Retinal fundus photograph; 1659x2212px.
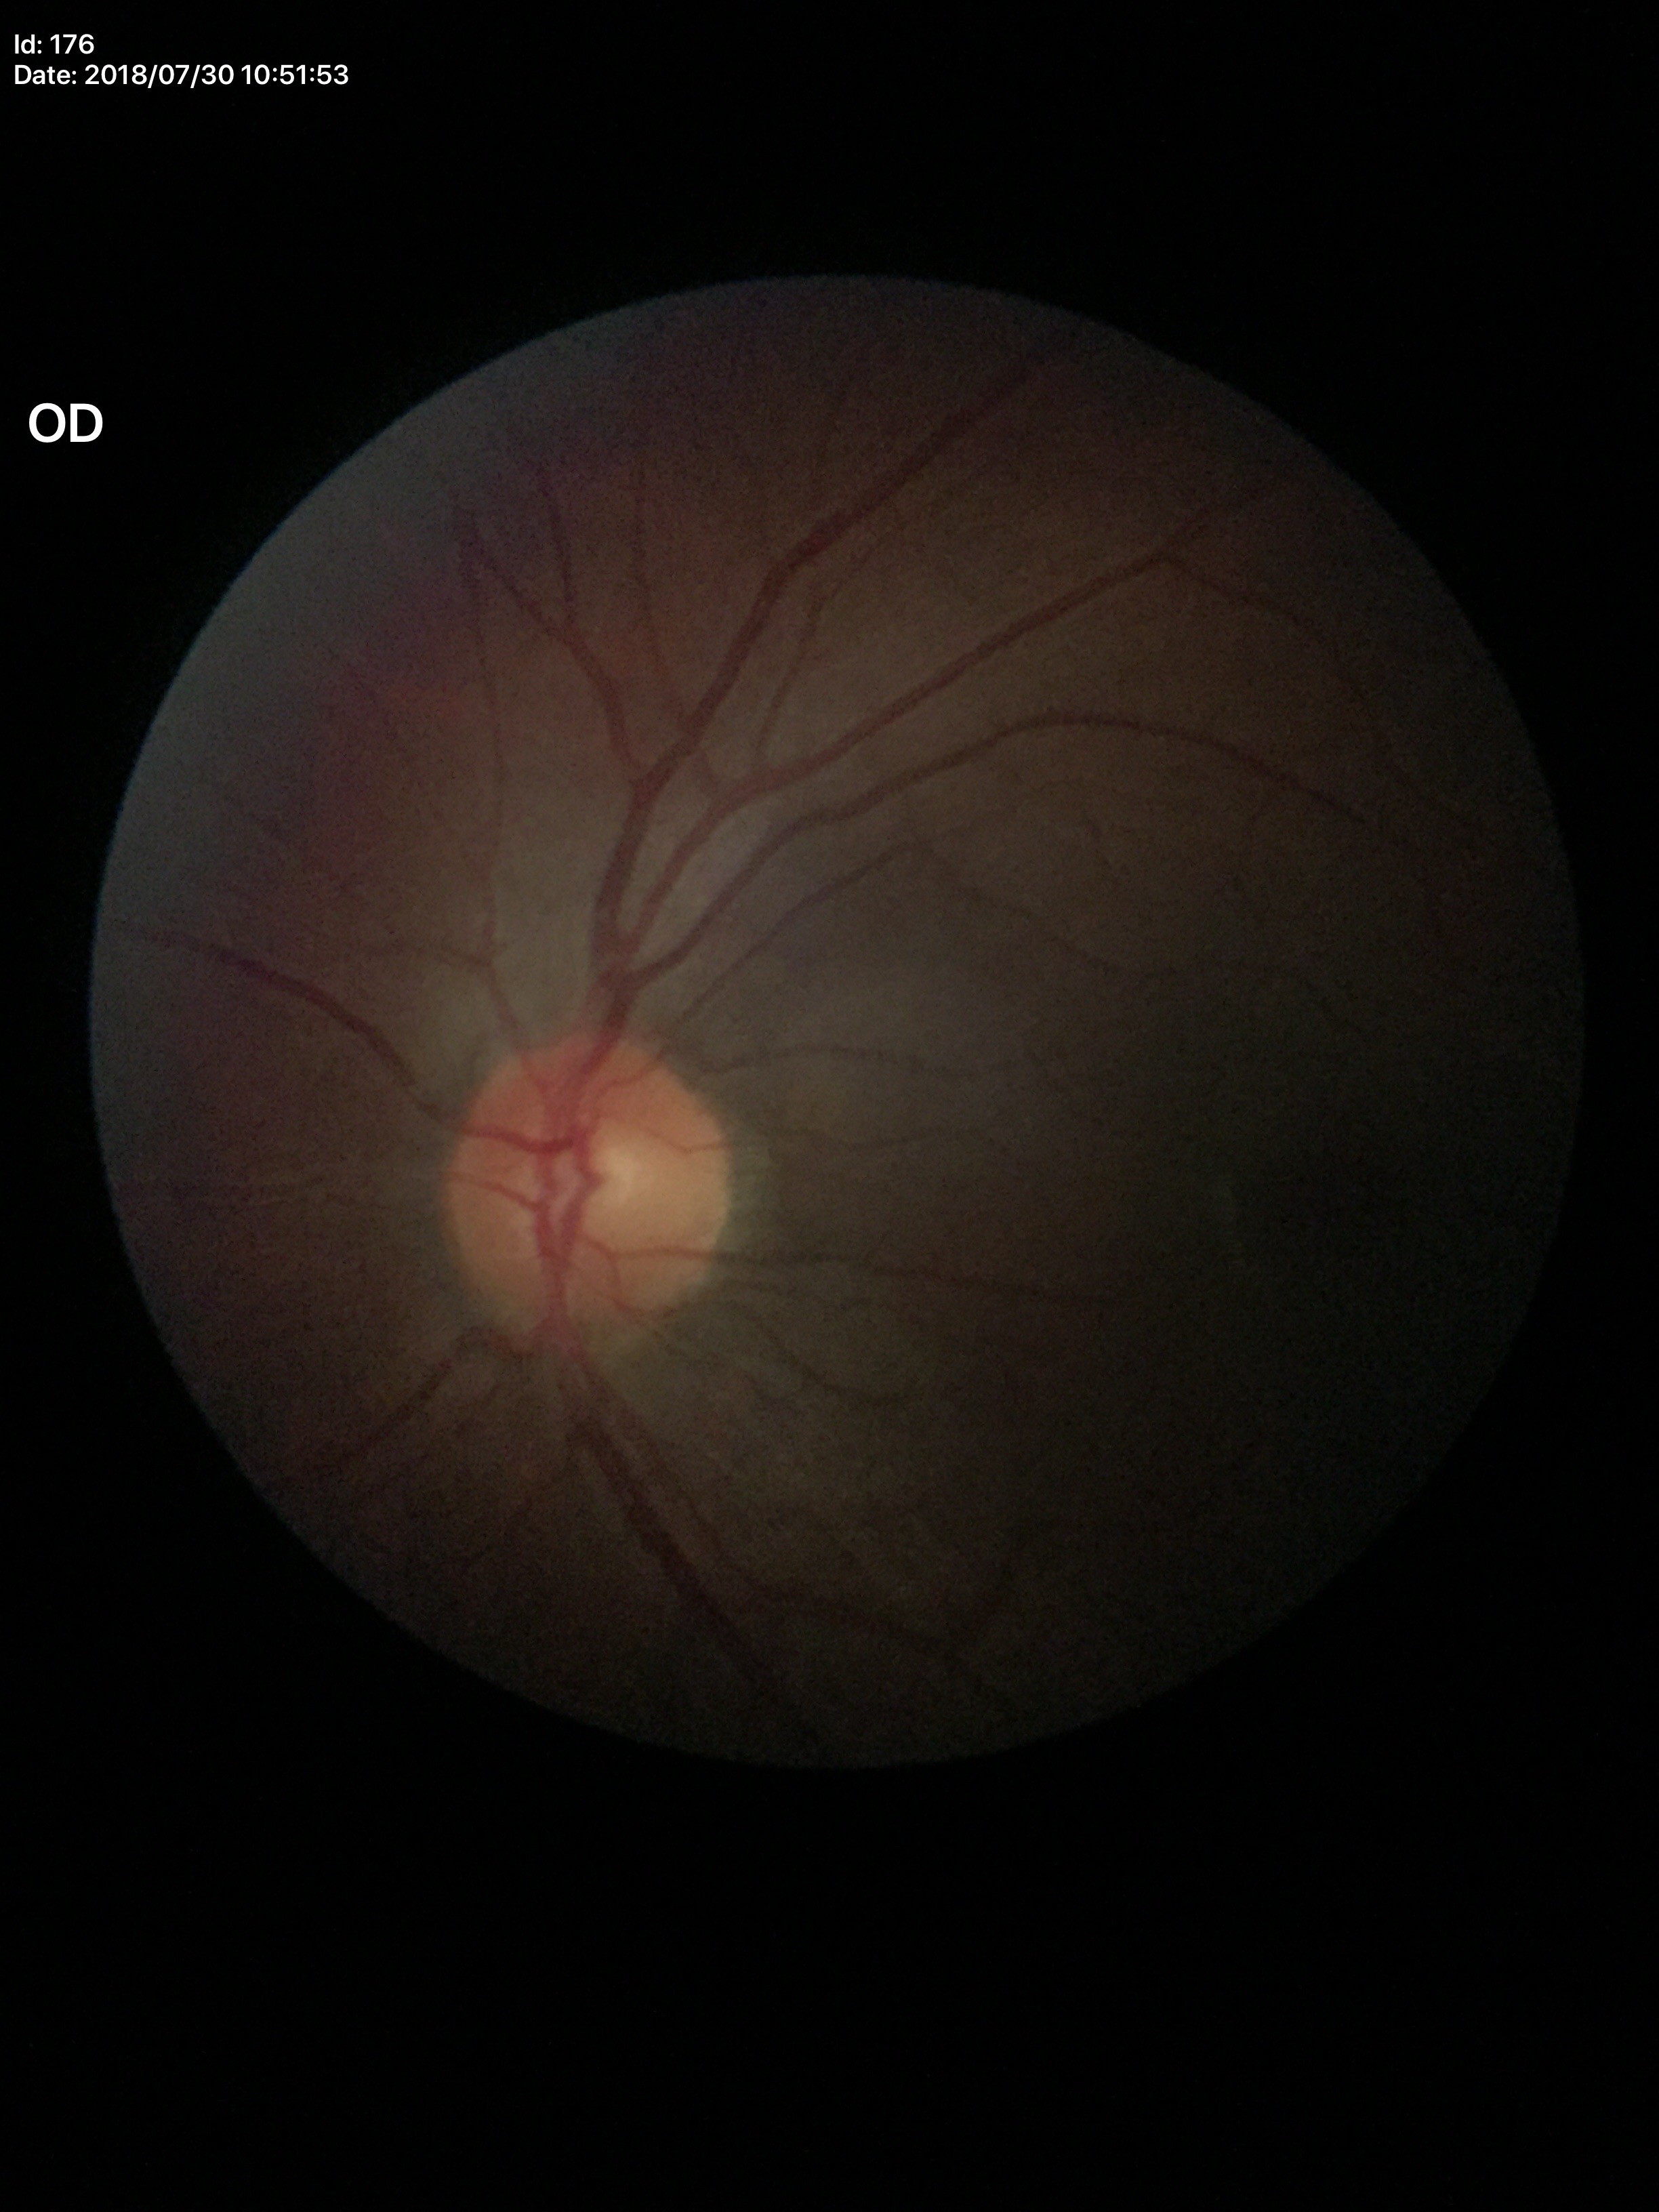
• Glaucoma decision: not suspect
• vertical CDR: 0.49
• horizontal cup-to-disc ratio: 0.48